45-degree field of view: 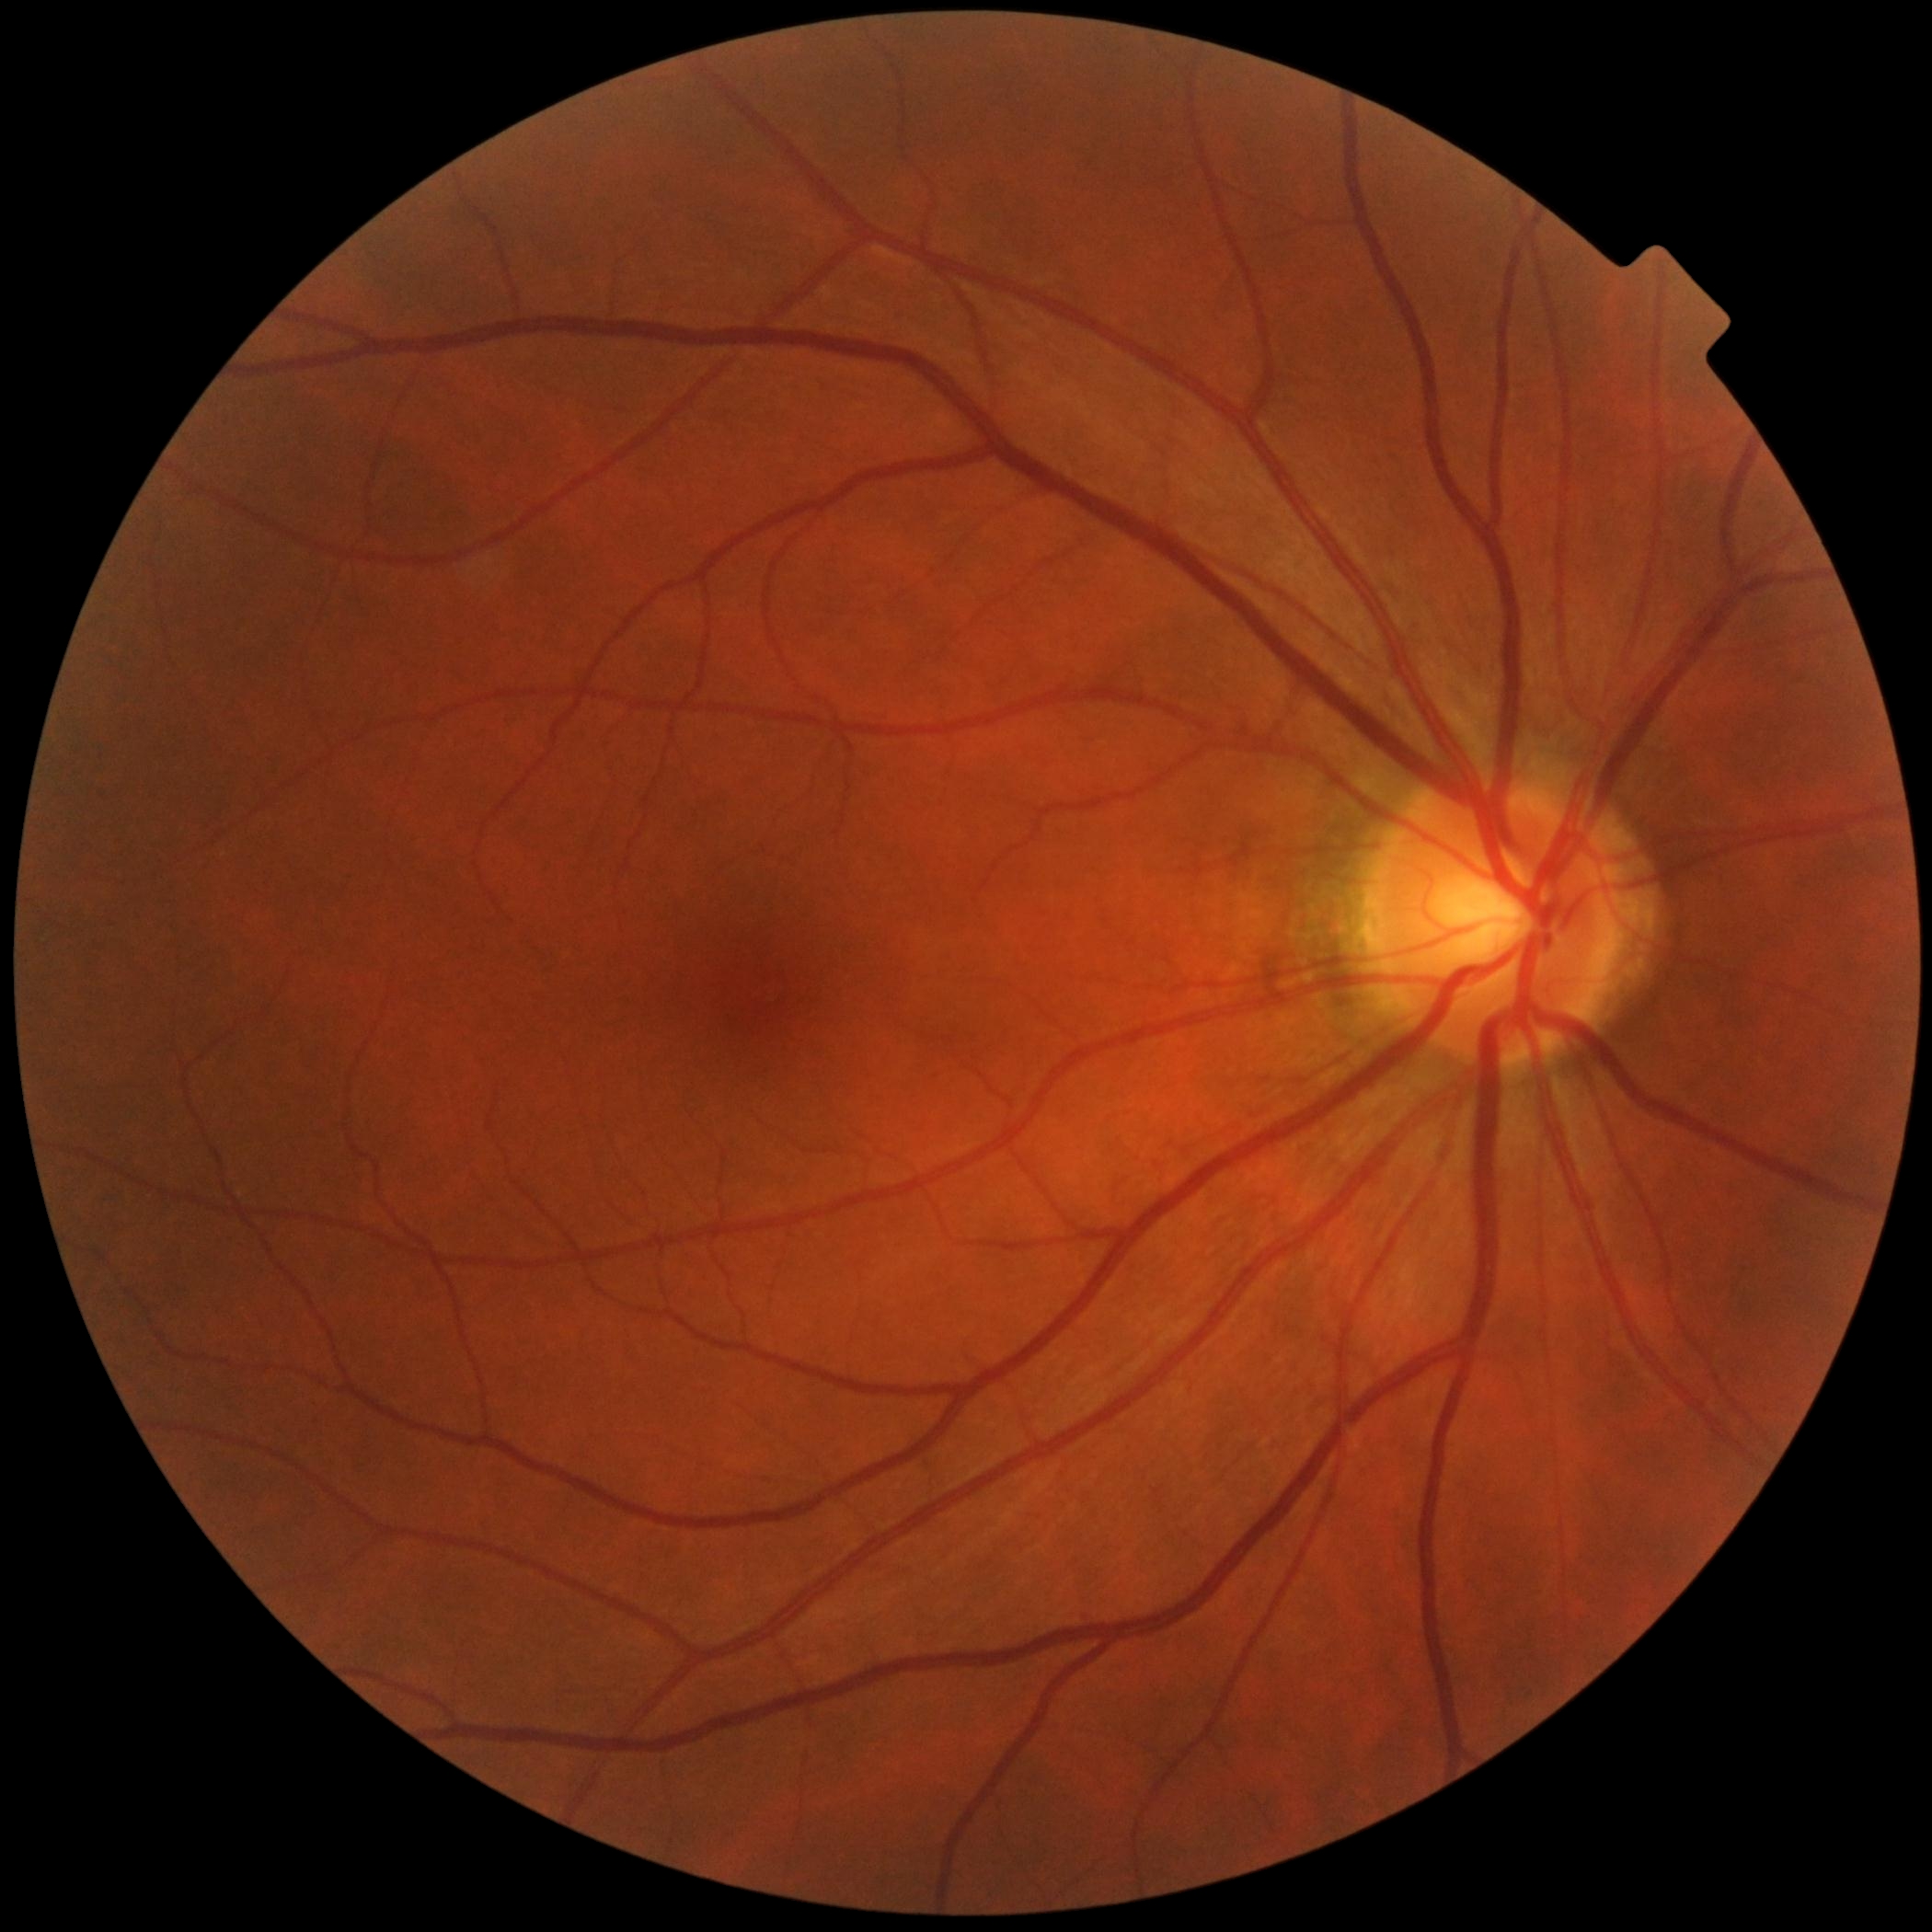

{
  "dr_grade": "grade 0"
}